Modified Davis grading:
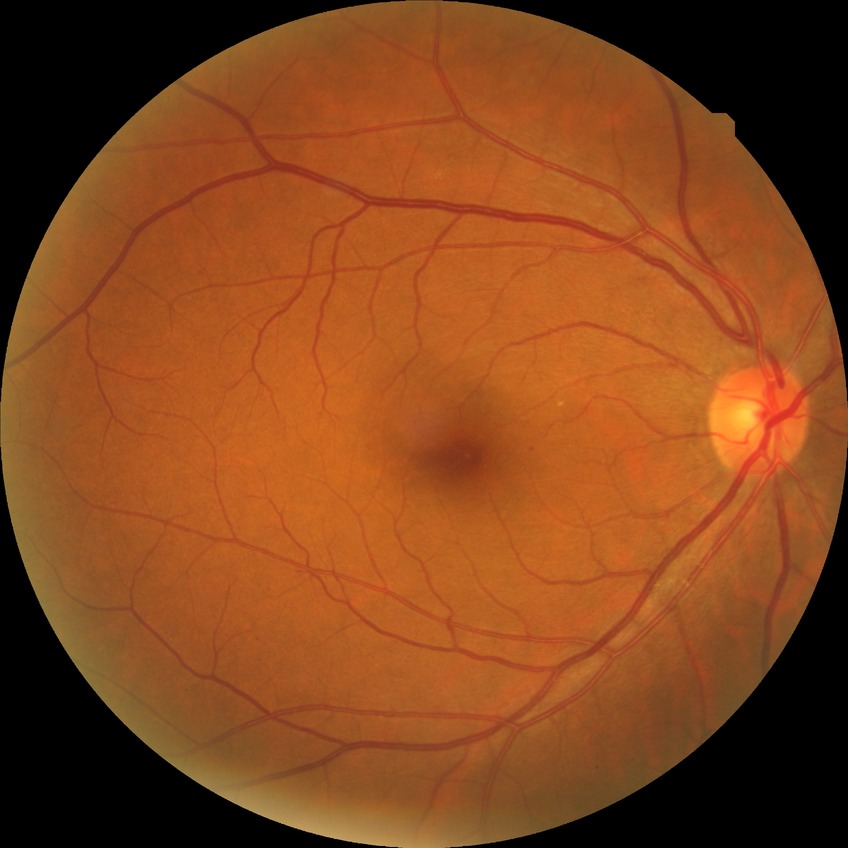

modified Davis classification=simple diabetic retinopathy.